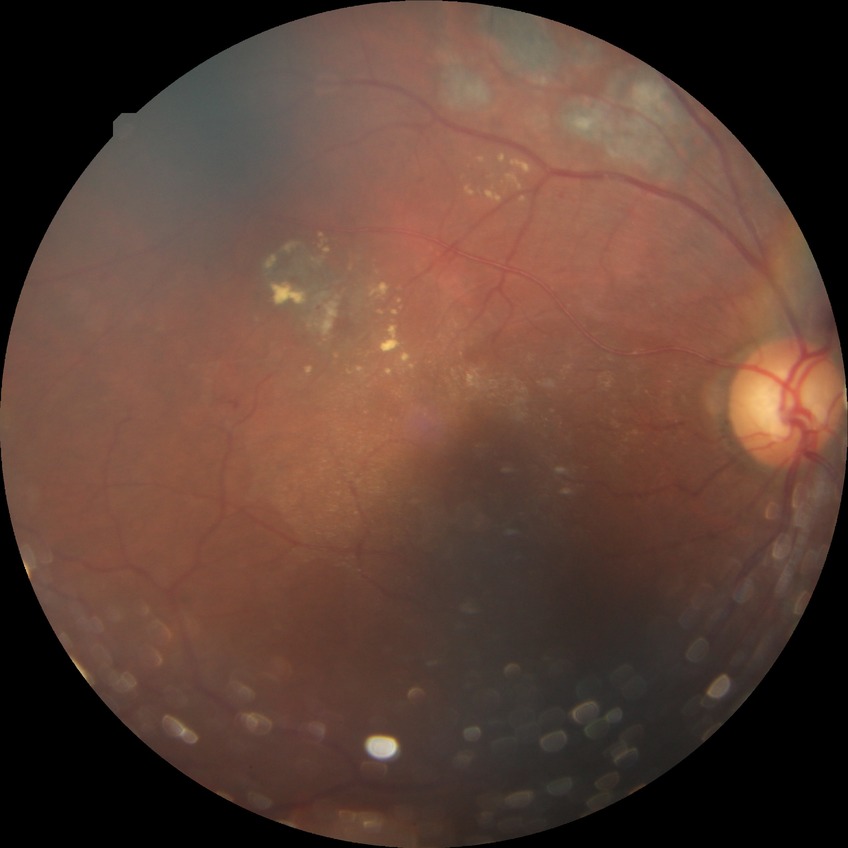
{"davis_grade": "proliferative diabetic retinopathy"}